717x726px: 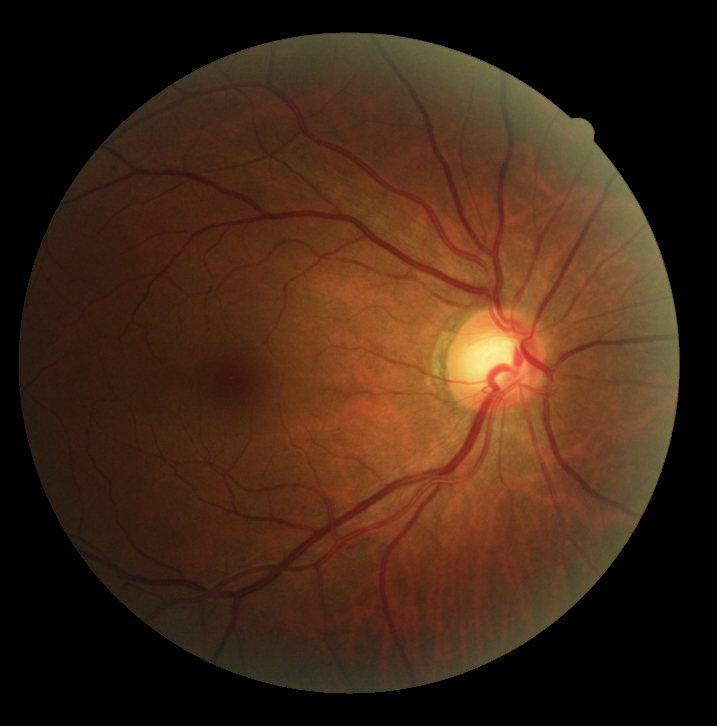 Diabetic retinopathy is grade 0.